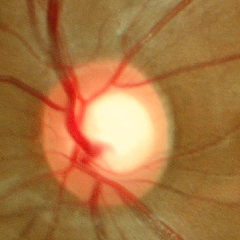 The image shows no glaucomatous optic neuropathy.